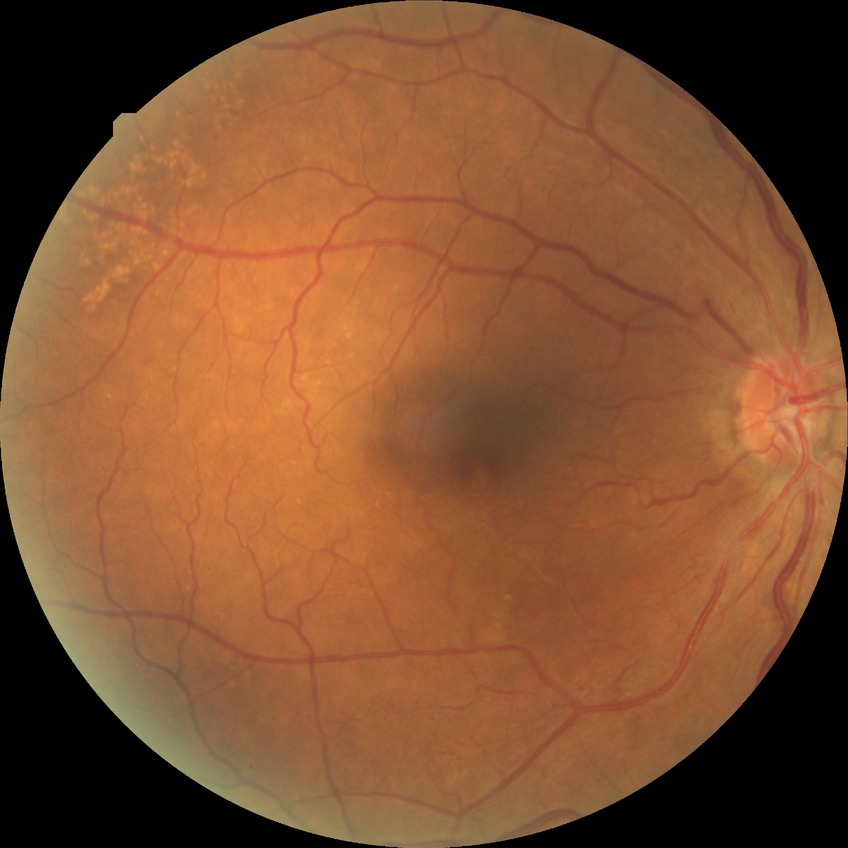

Retinopathy stage: no diabetic retinopathy.